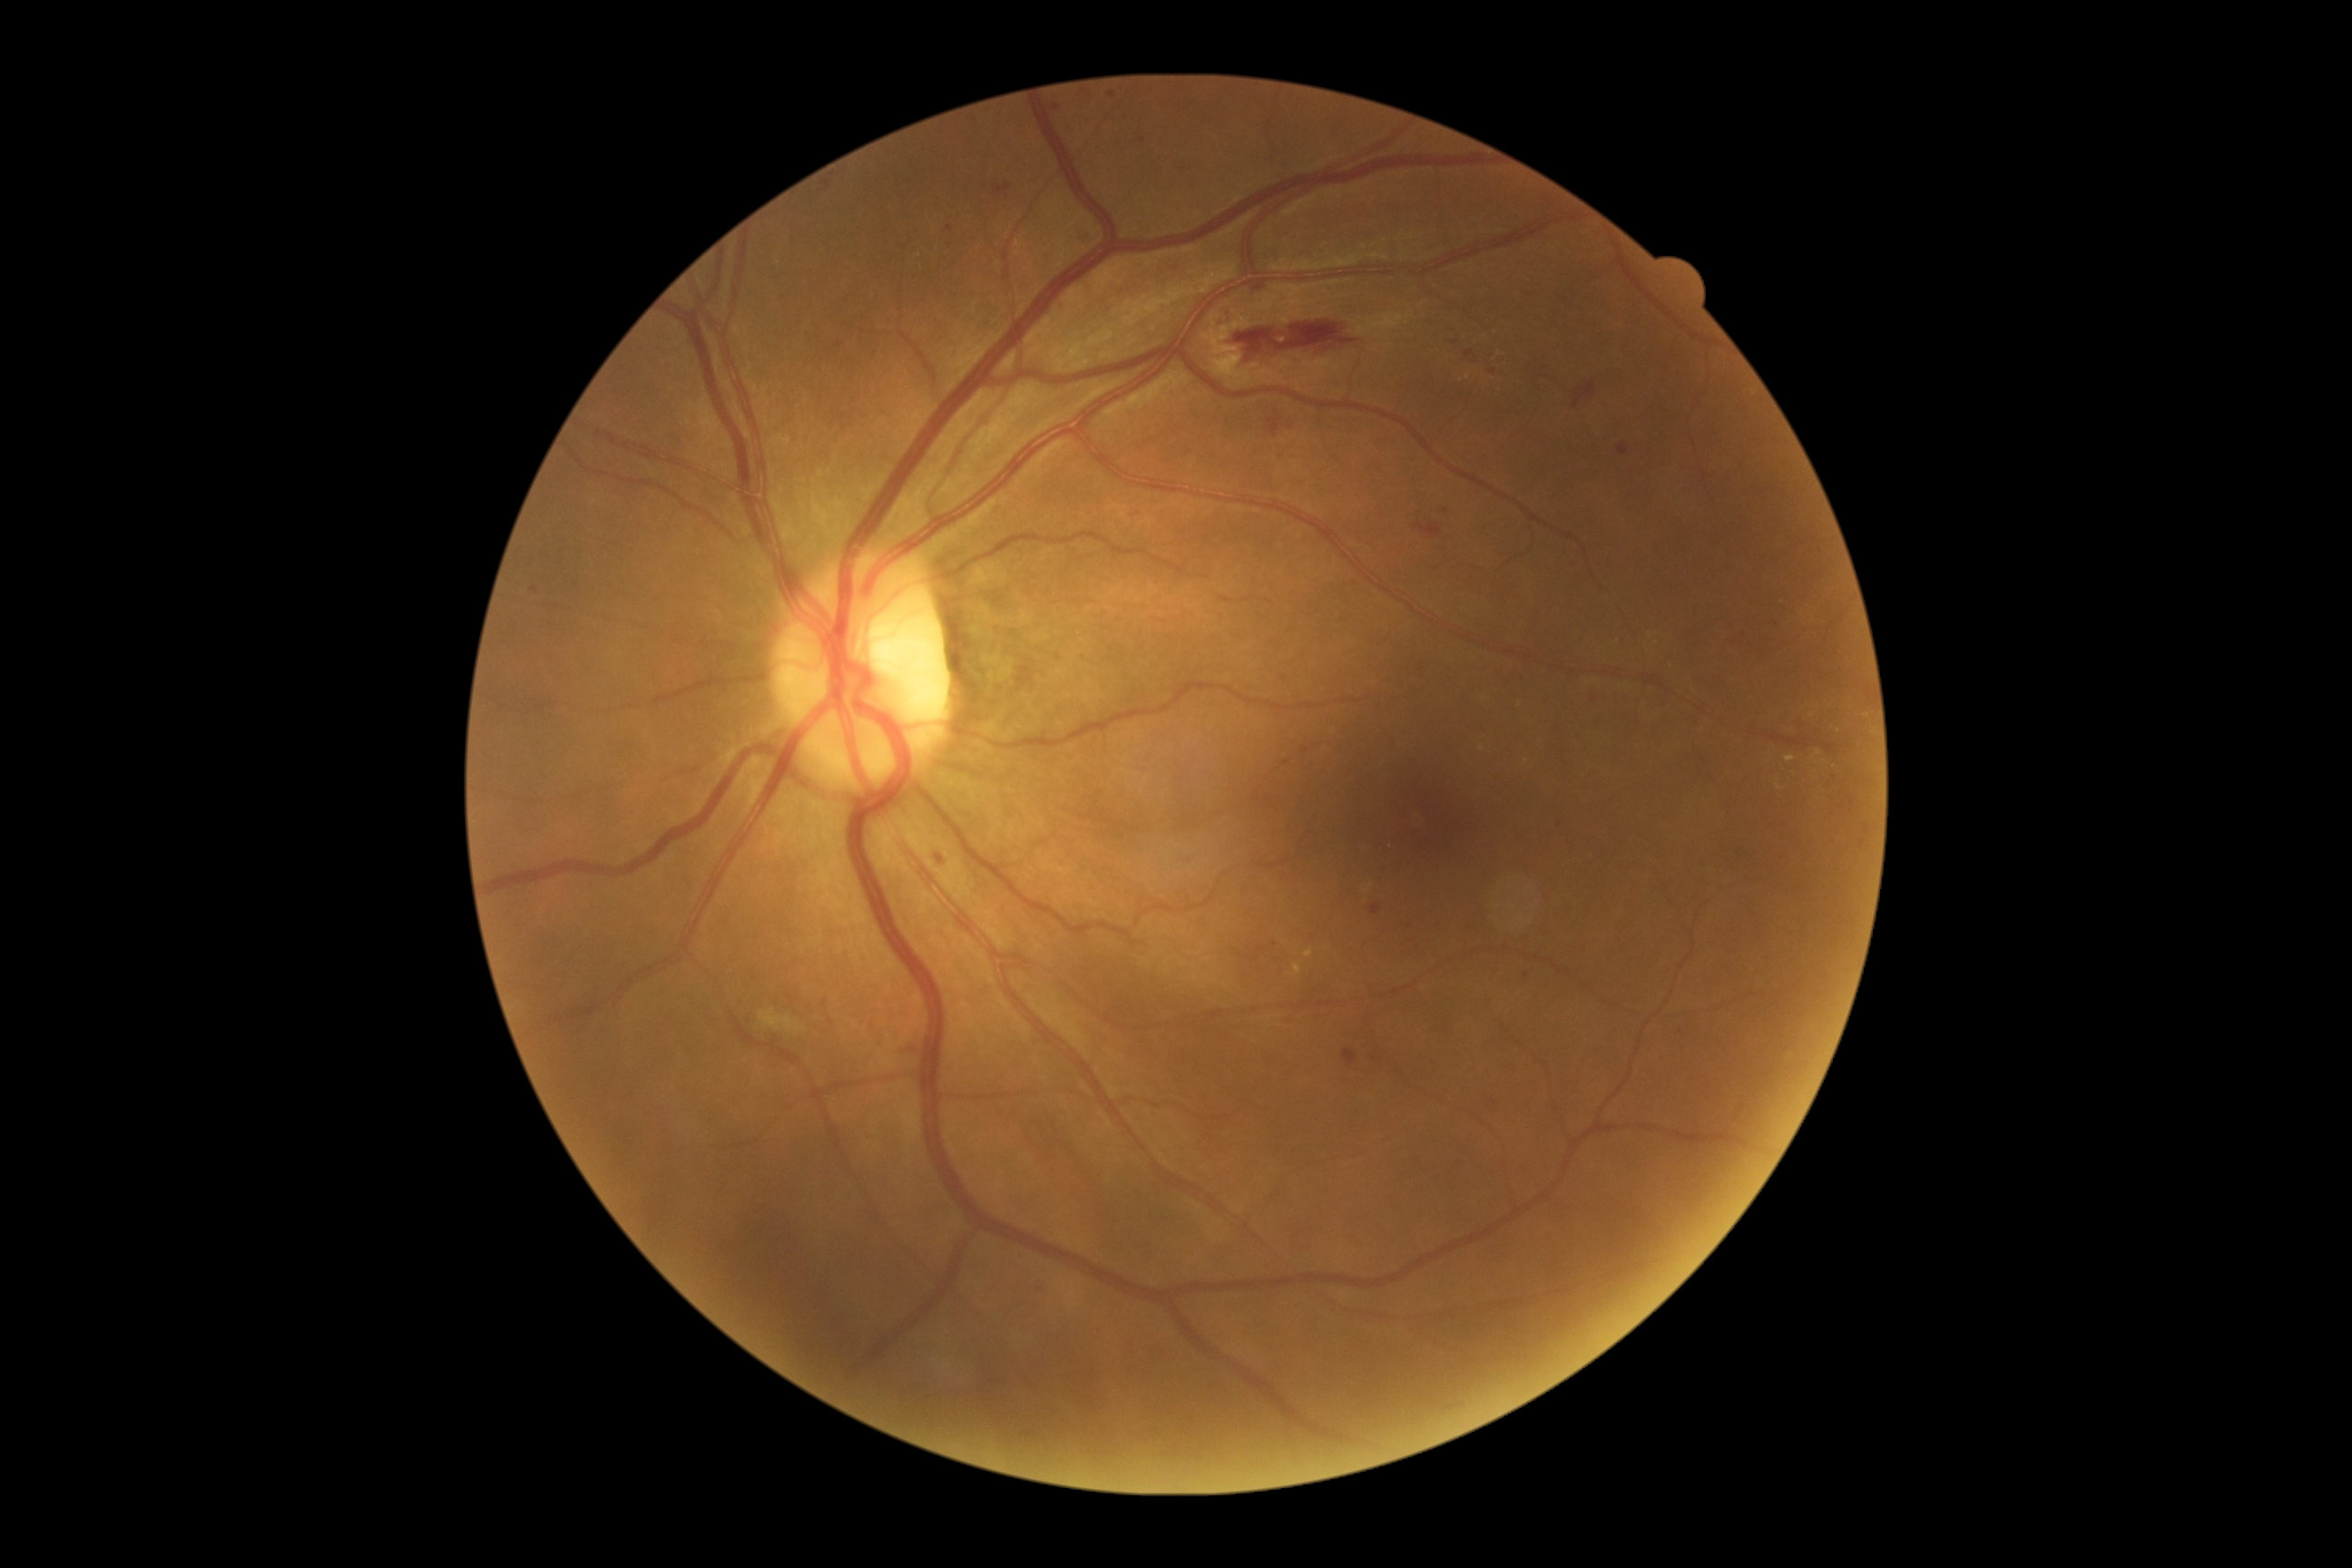 DR class: non-proliferative diabetic retinopathy. DR grade is 2/4.